Graded on the modified Davis scale
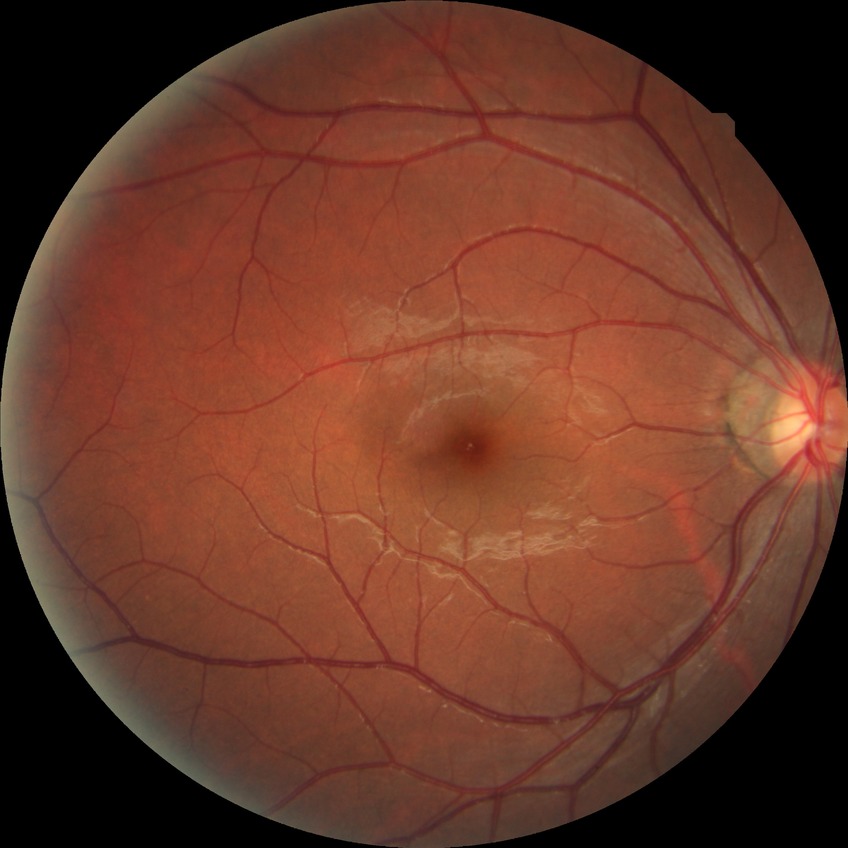

davis_grade: NDR (no diabetic retinopathy)